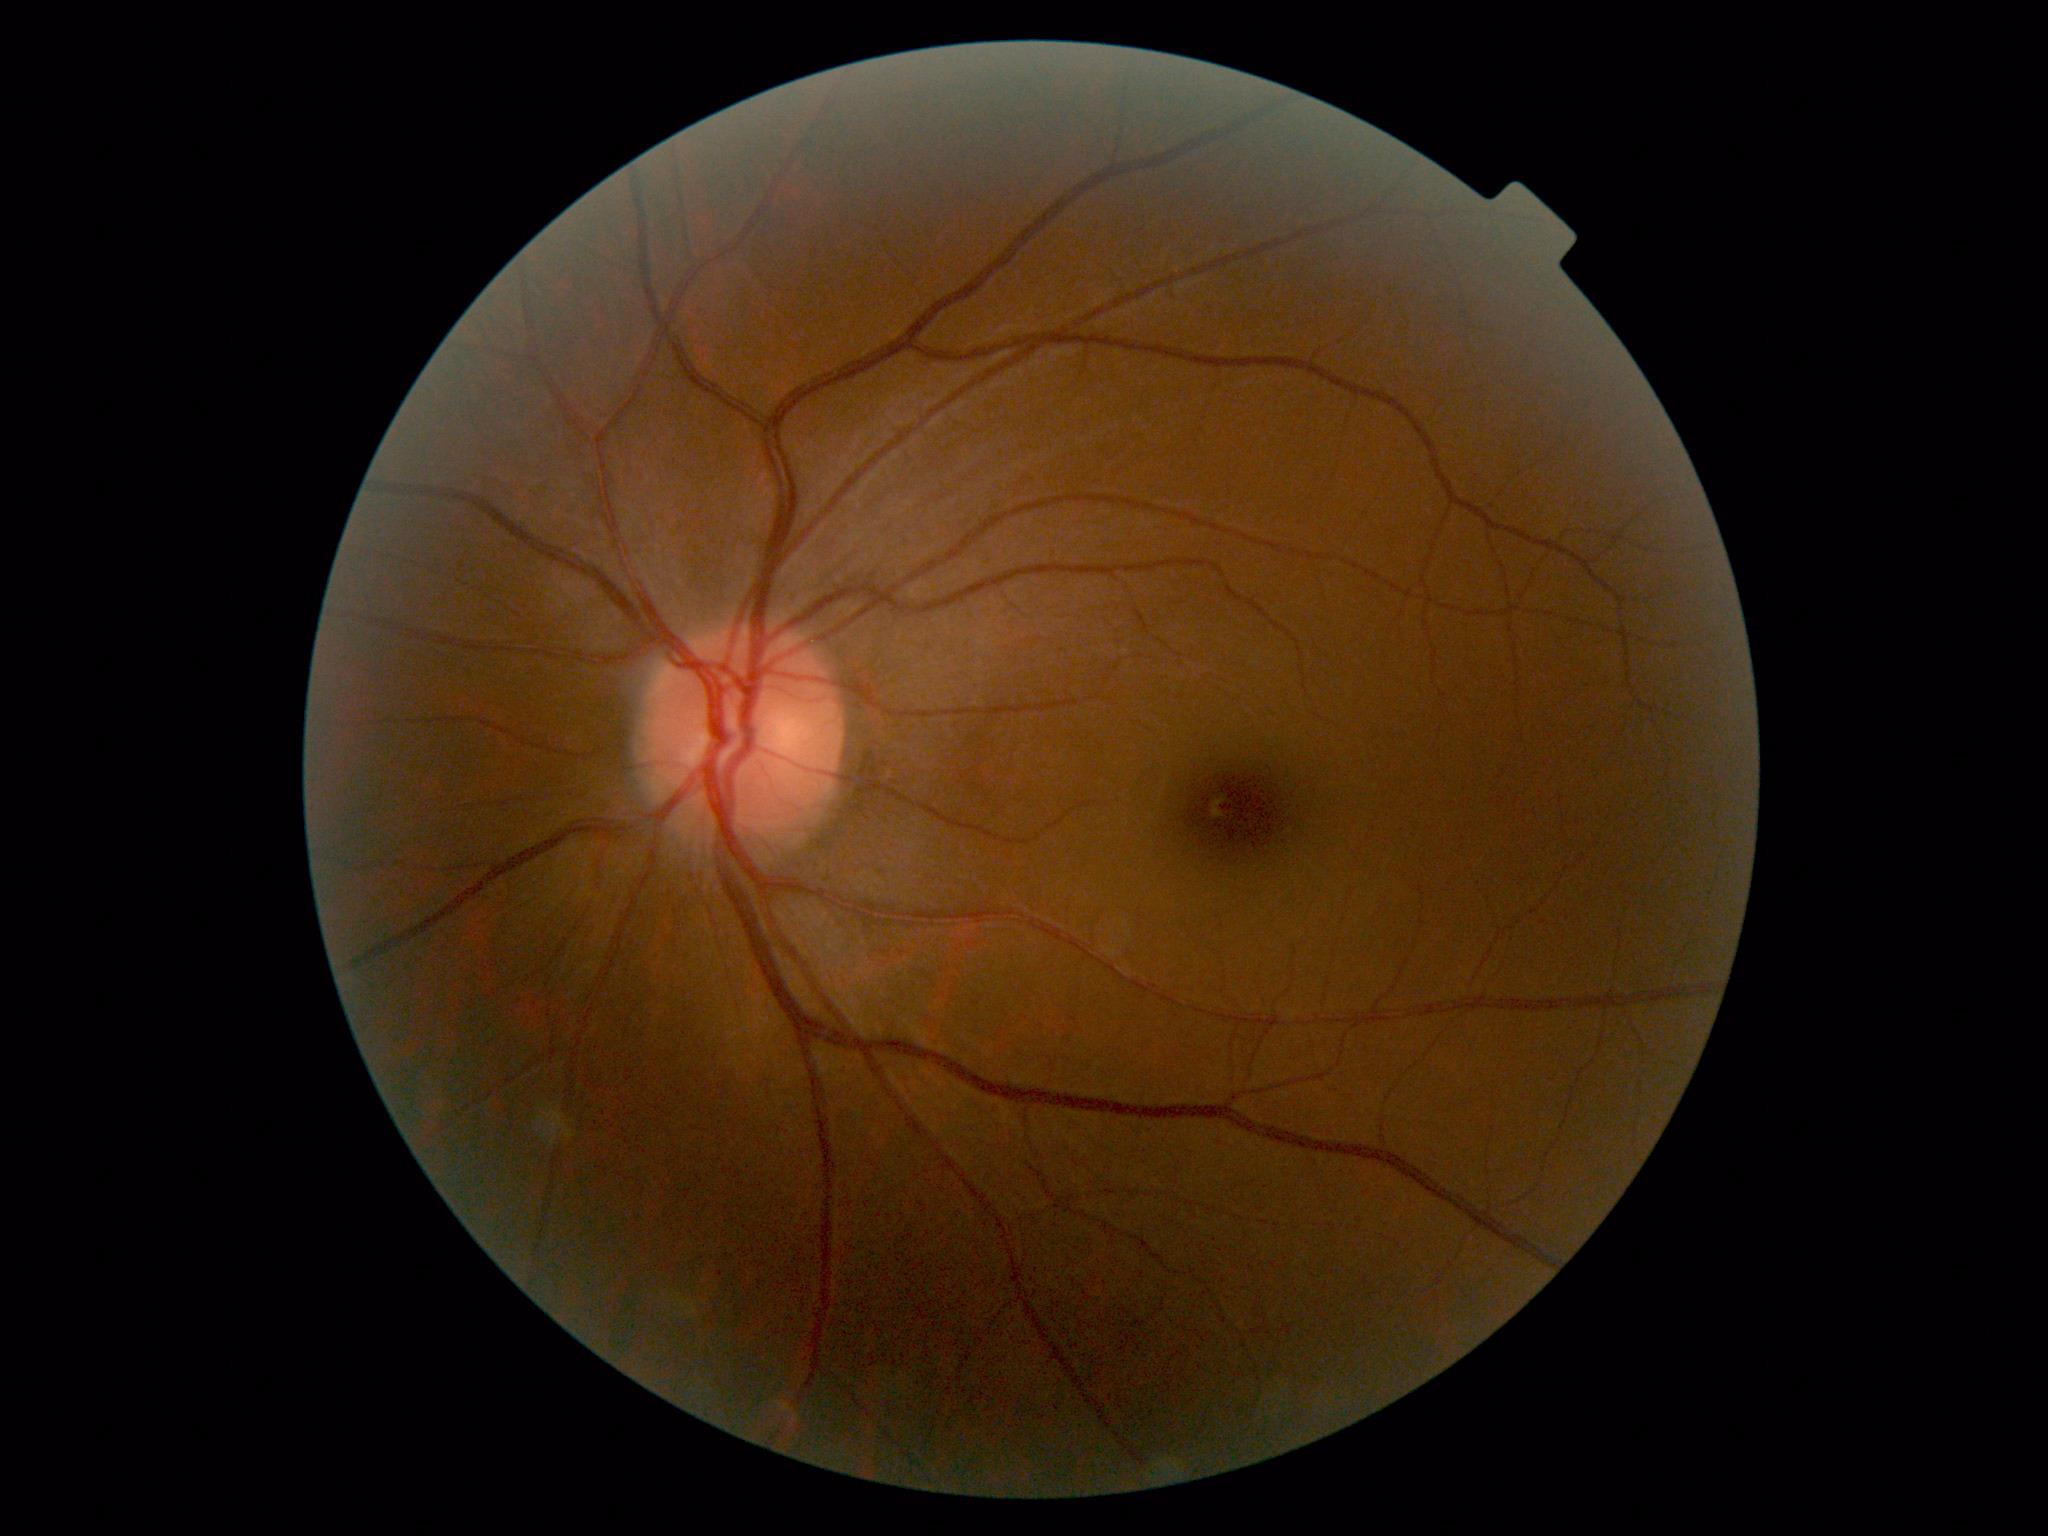 Diabetic retinopathy grade is 0 (no apparent retinopathy).